640 by 480 pixels · infant wide-field retinal image
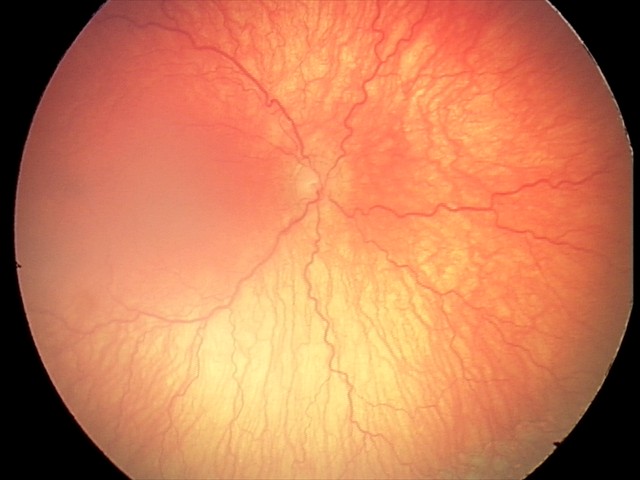 Series diagnosed as aggressive ROP (A-ROP).